CFP: 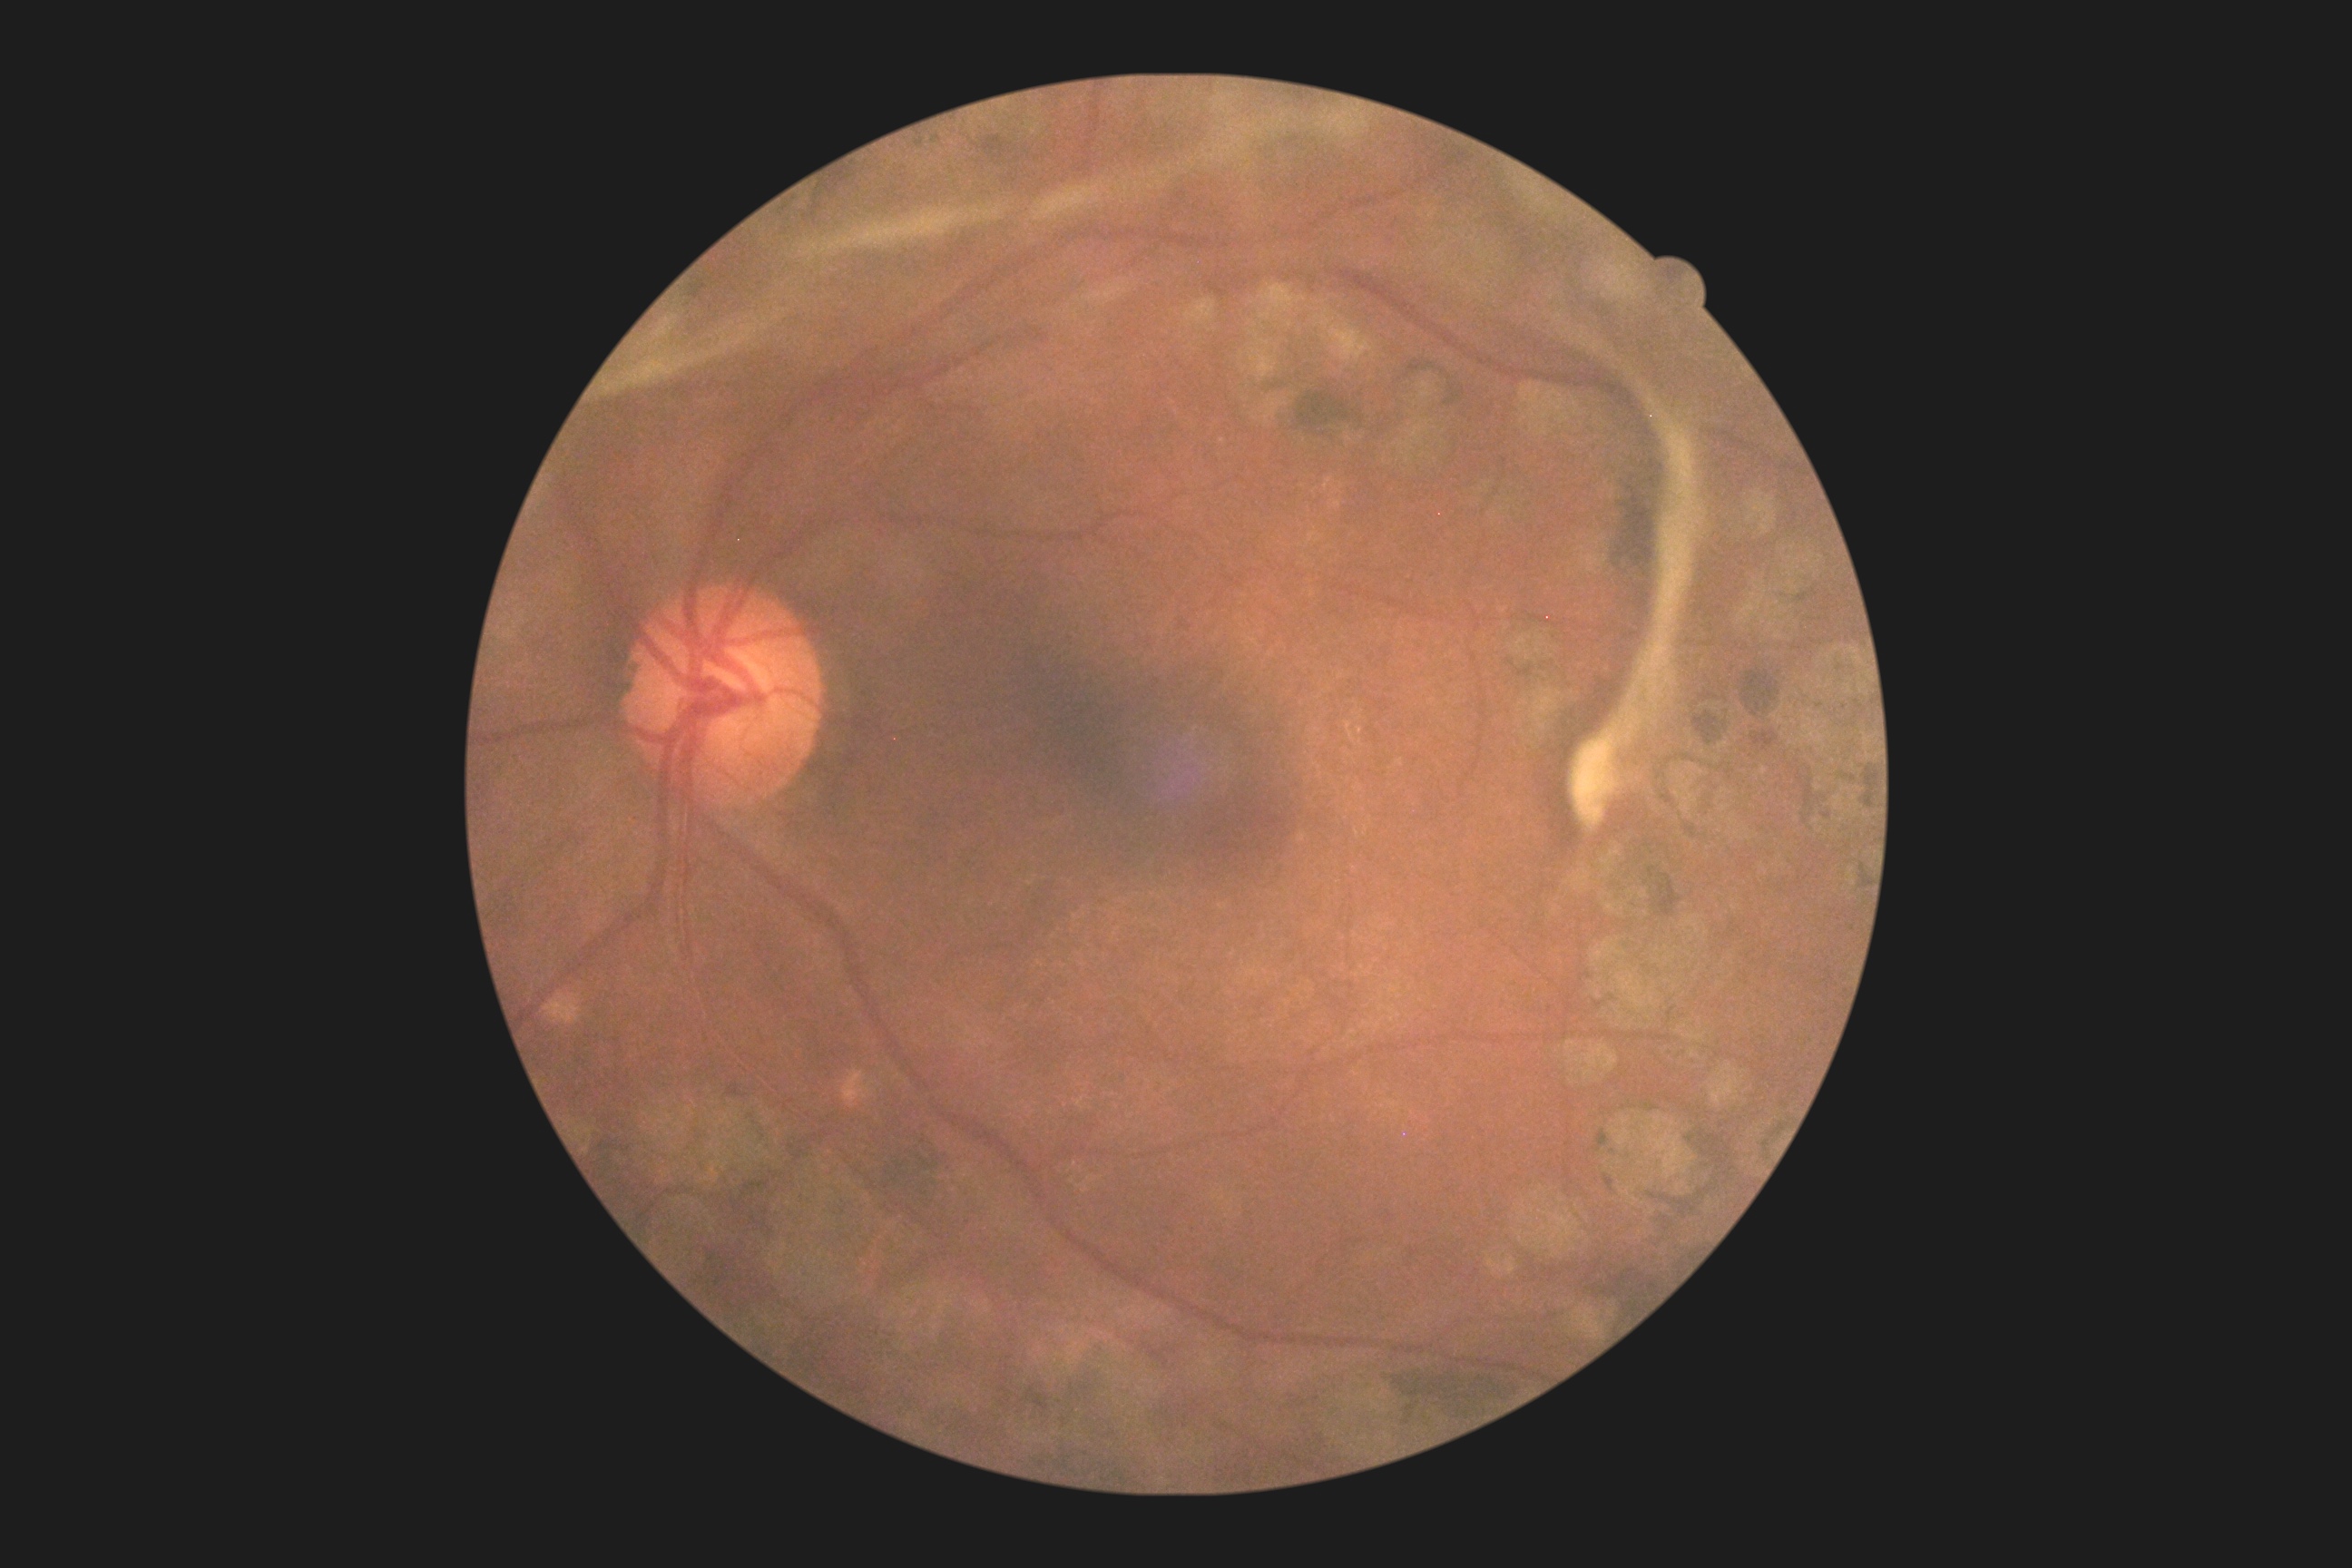
Diabetic retinopathy (DR) is 4/4.